45° field of view; no pharmacologic dilation; color fundus photograph — 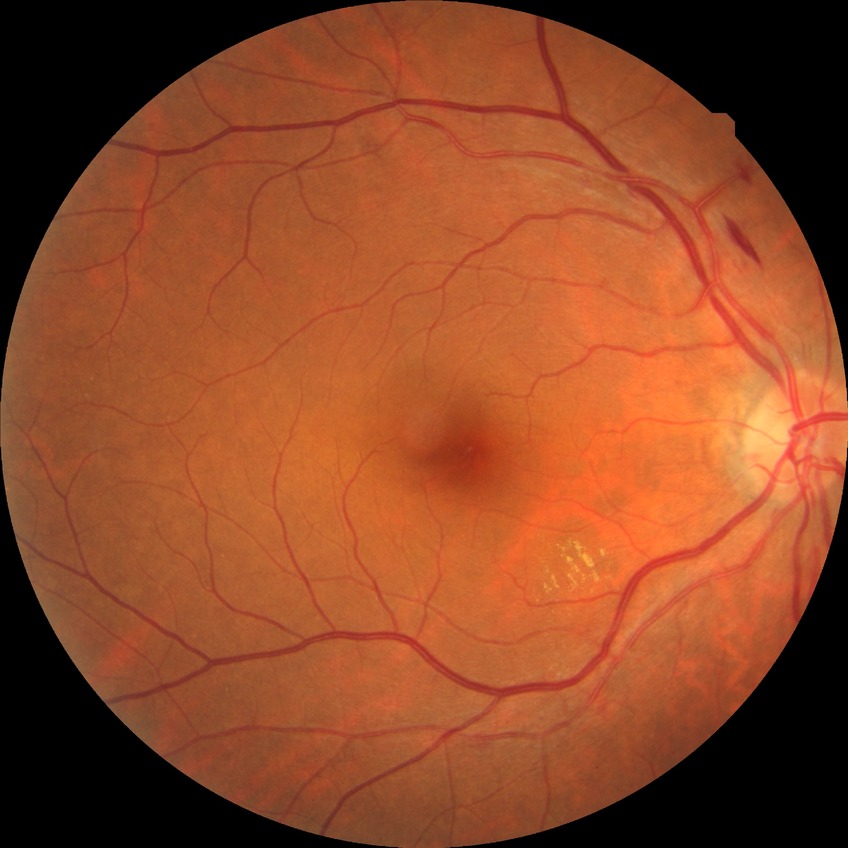
Diabetic retinopathy (DR) is SDR (simple diabetic retinopathy).